Nidek AFC-330:
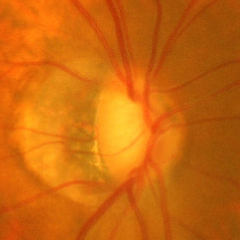 Demonstrates advanced glaucoma. (Criteria: near-total cupping of the optic nerve head, with or without severe visual field loss within the central 10 degrees of fixation.)